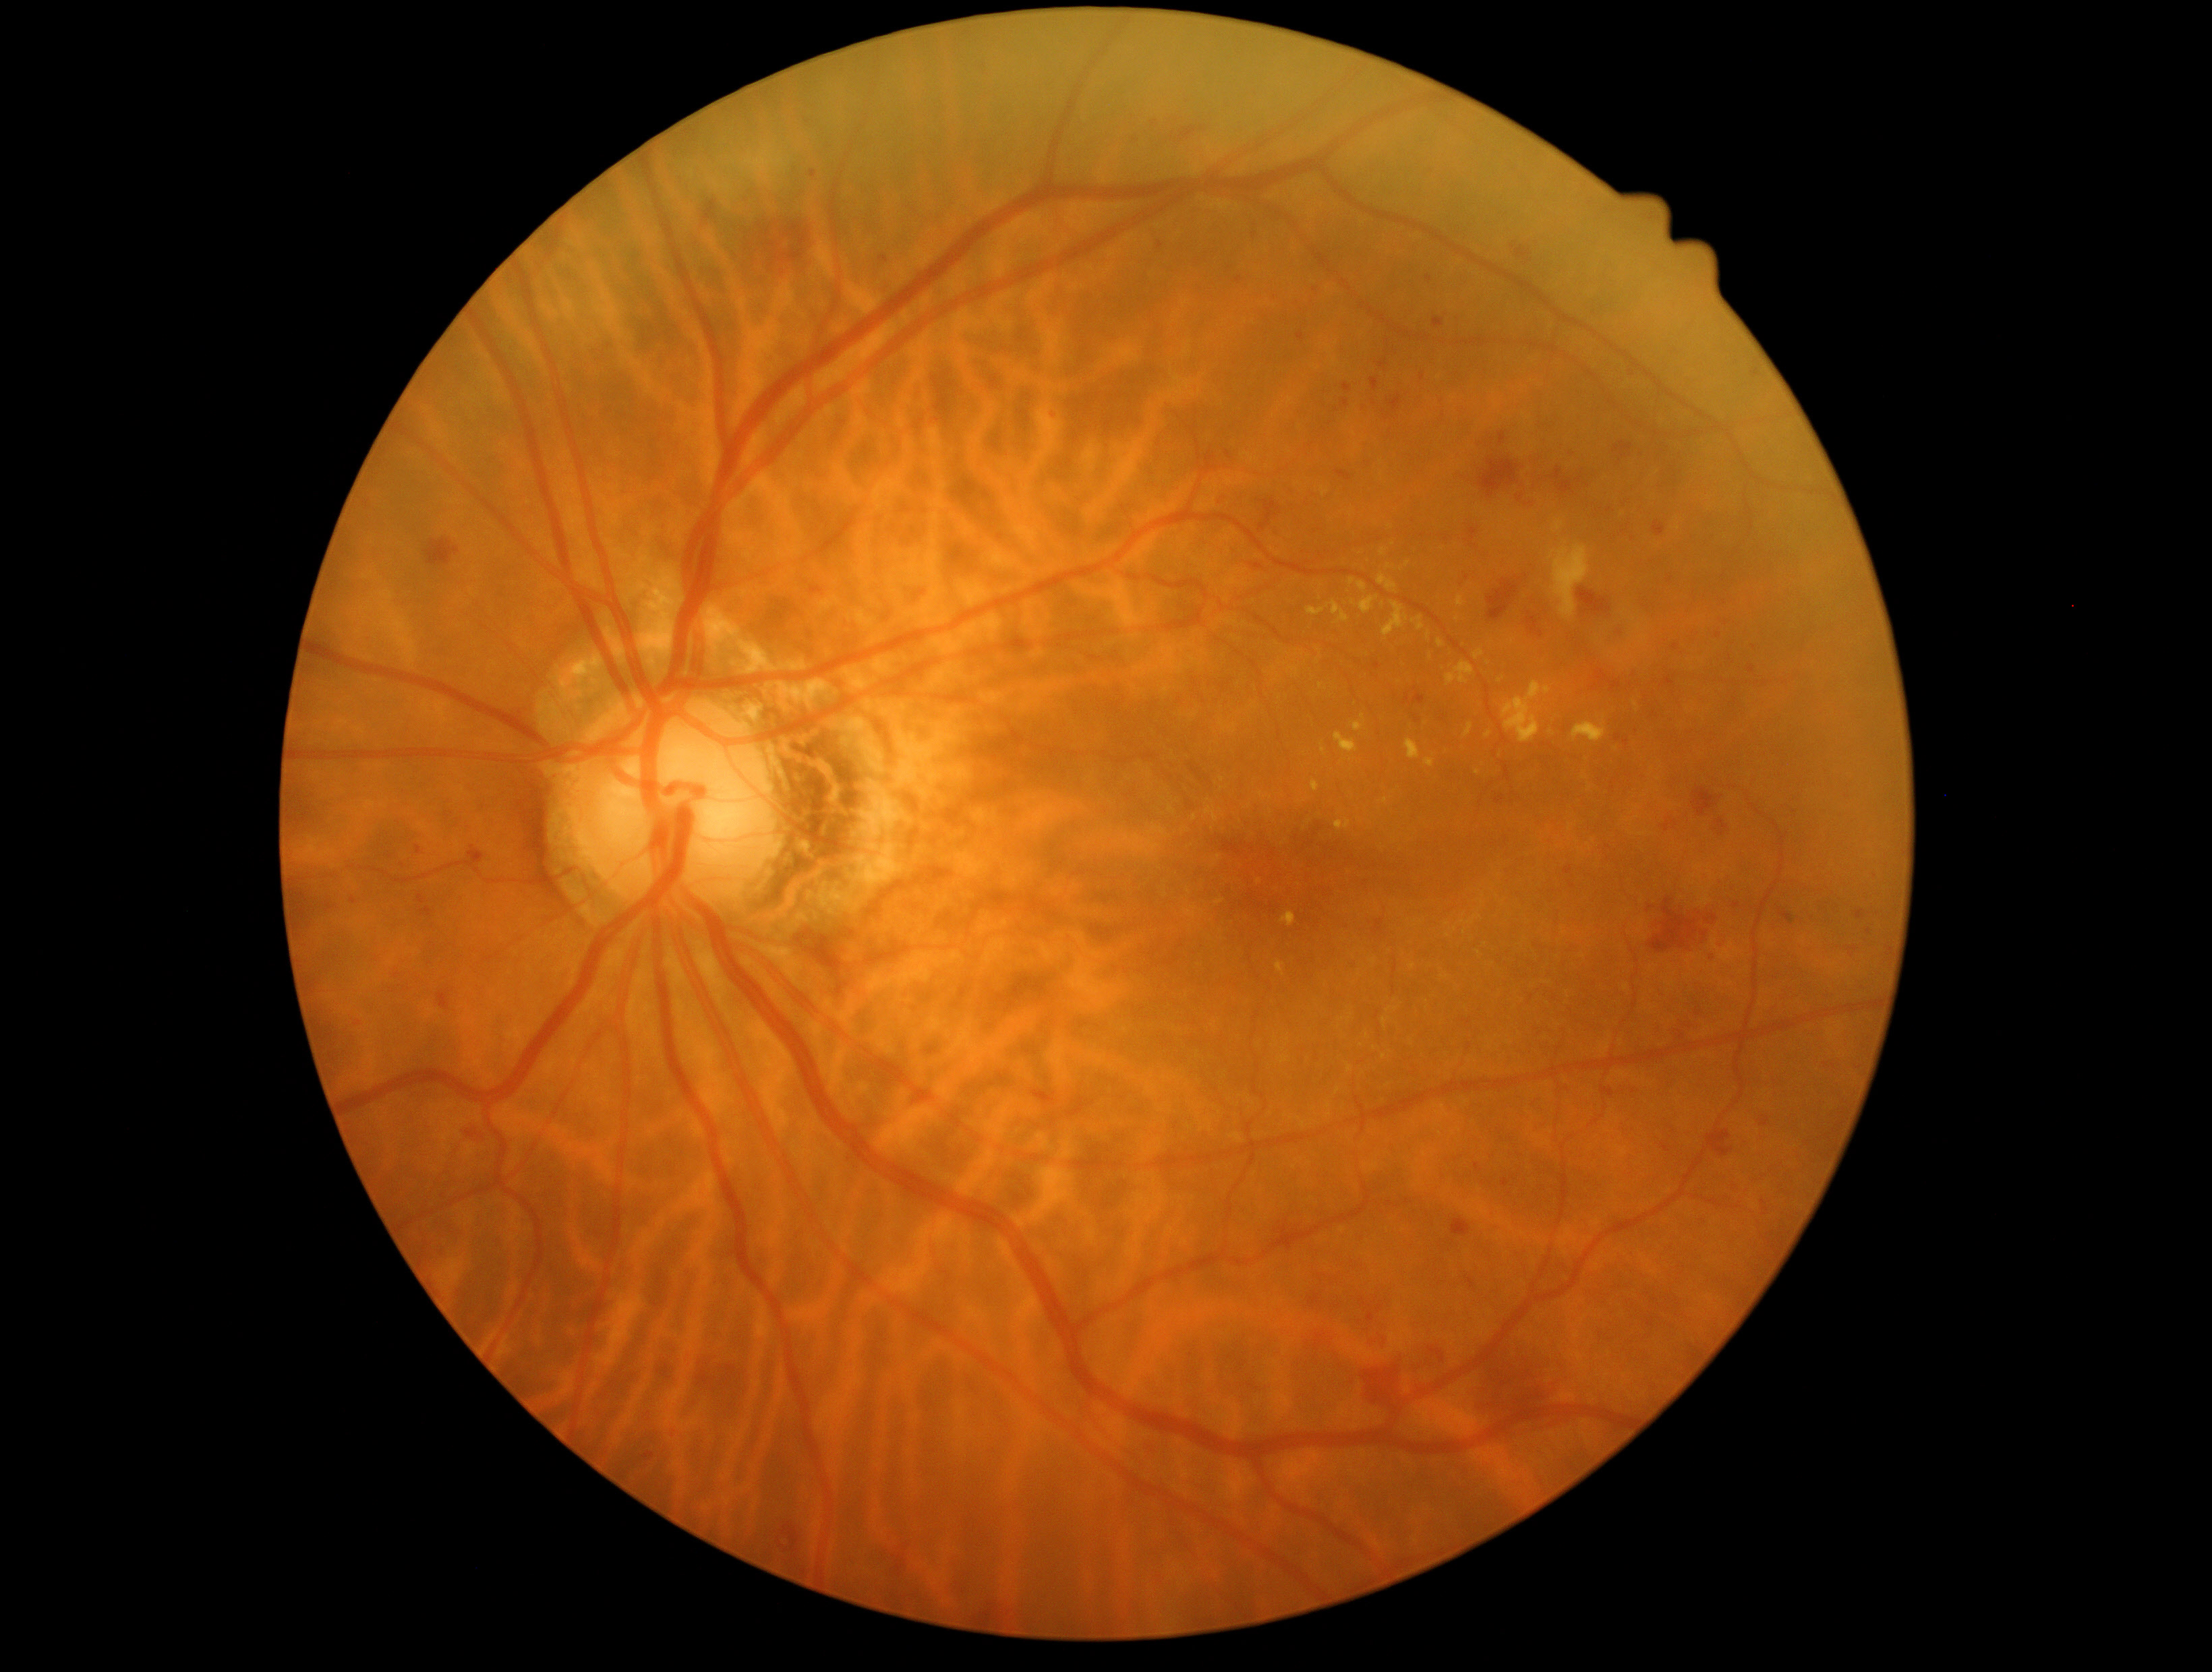

DR severity is grade 2 (moderate NPDR).
EXs are present, including at <region>1321, 487, 1329, 496</region>, <region>1335, 822, 1351, 831</region>, <region>1573, 722, 1607, 744</region>, <region>1206, 808, 1219, 823</region>, <region>1425, 758, 1434, 769</region>, <region>1359, 595, 1380, 616</region>, <region>1475, 651, 1484, 660</region>, <region>1349, 578, 1356, 586</region>.
EXs (small, approximate centers) near (x=1512, y=641), (x=1386, y=802), (x=1383, y=605), (x=1220, y=902), (x=1438, y=1114), (x=1552, y=733), (x=1218, y=859), (x=1465, y=933).
HEs are present, including at <region>933, 371, 956, 392</region>, <region>989, 377, 1001, 390</region>, <region>1452, 1218, 1471, 1237</region>, <region>455, 1120, 489, 1148</region>, <region>1627, 533, 1639, 543</region>, <region>811, 171, 817, 179</region>, <region>1251, 564, 1264, 571</region>, <region>1660, 676, 1676, 688</region>, <region>1247, 1407, 1273, 1430</region>, <region>1502, 1179, 1511, 1187</region>, <region>1747, 667, 1755, 675</region>, <region>1695, 1009, 1703, 1016</region>, <region>1389, 394, 1402, 413</region>, <region>1468, 1344, 1572, 1429</region>, <region>1402, 694, 1426, 706</region>.
HEs (small, approximate centers) near (x=1387, y=342), (x=1155, y=124), (x=330, y=907).